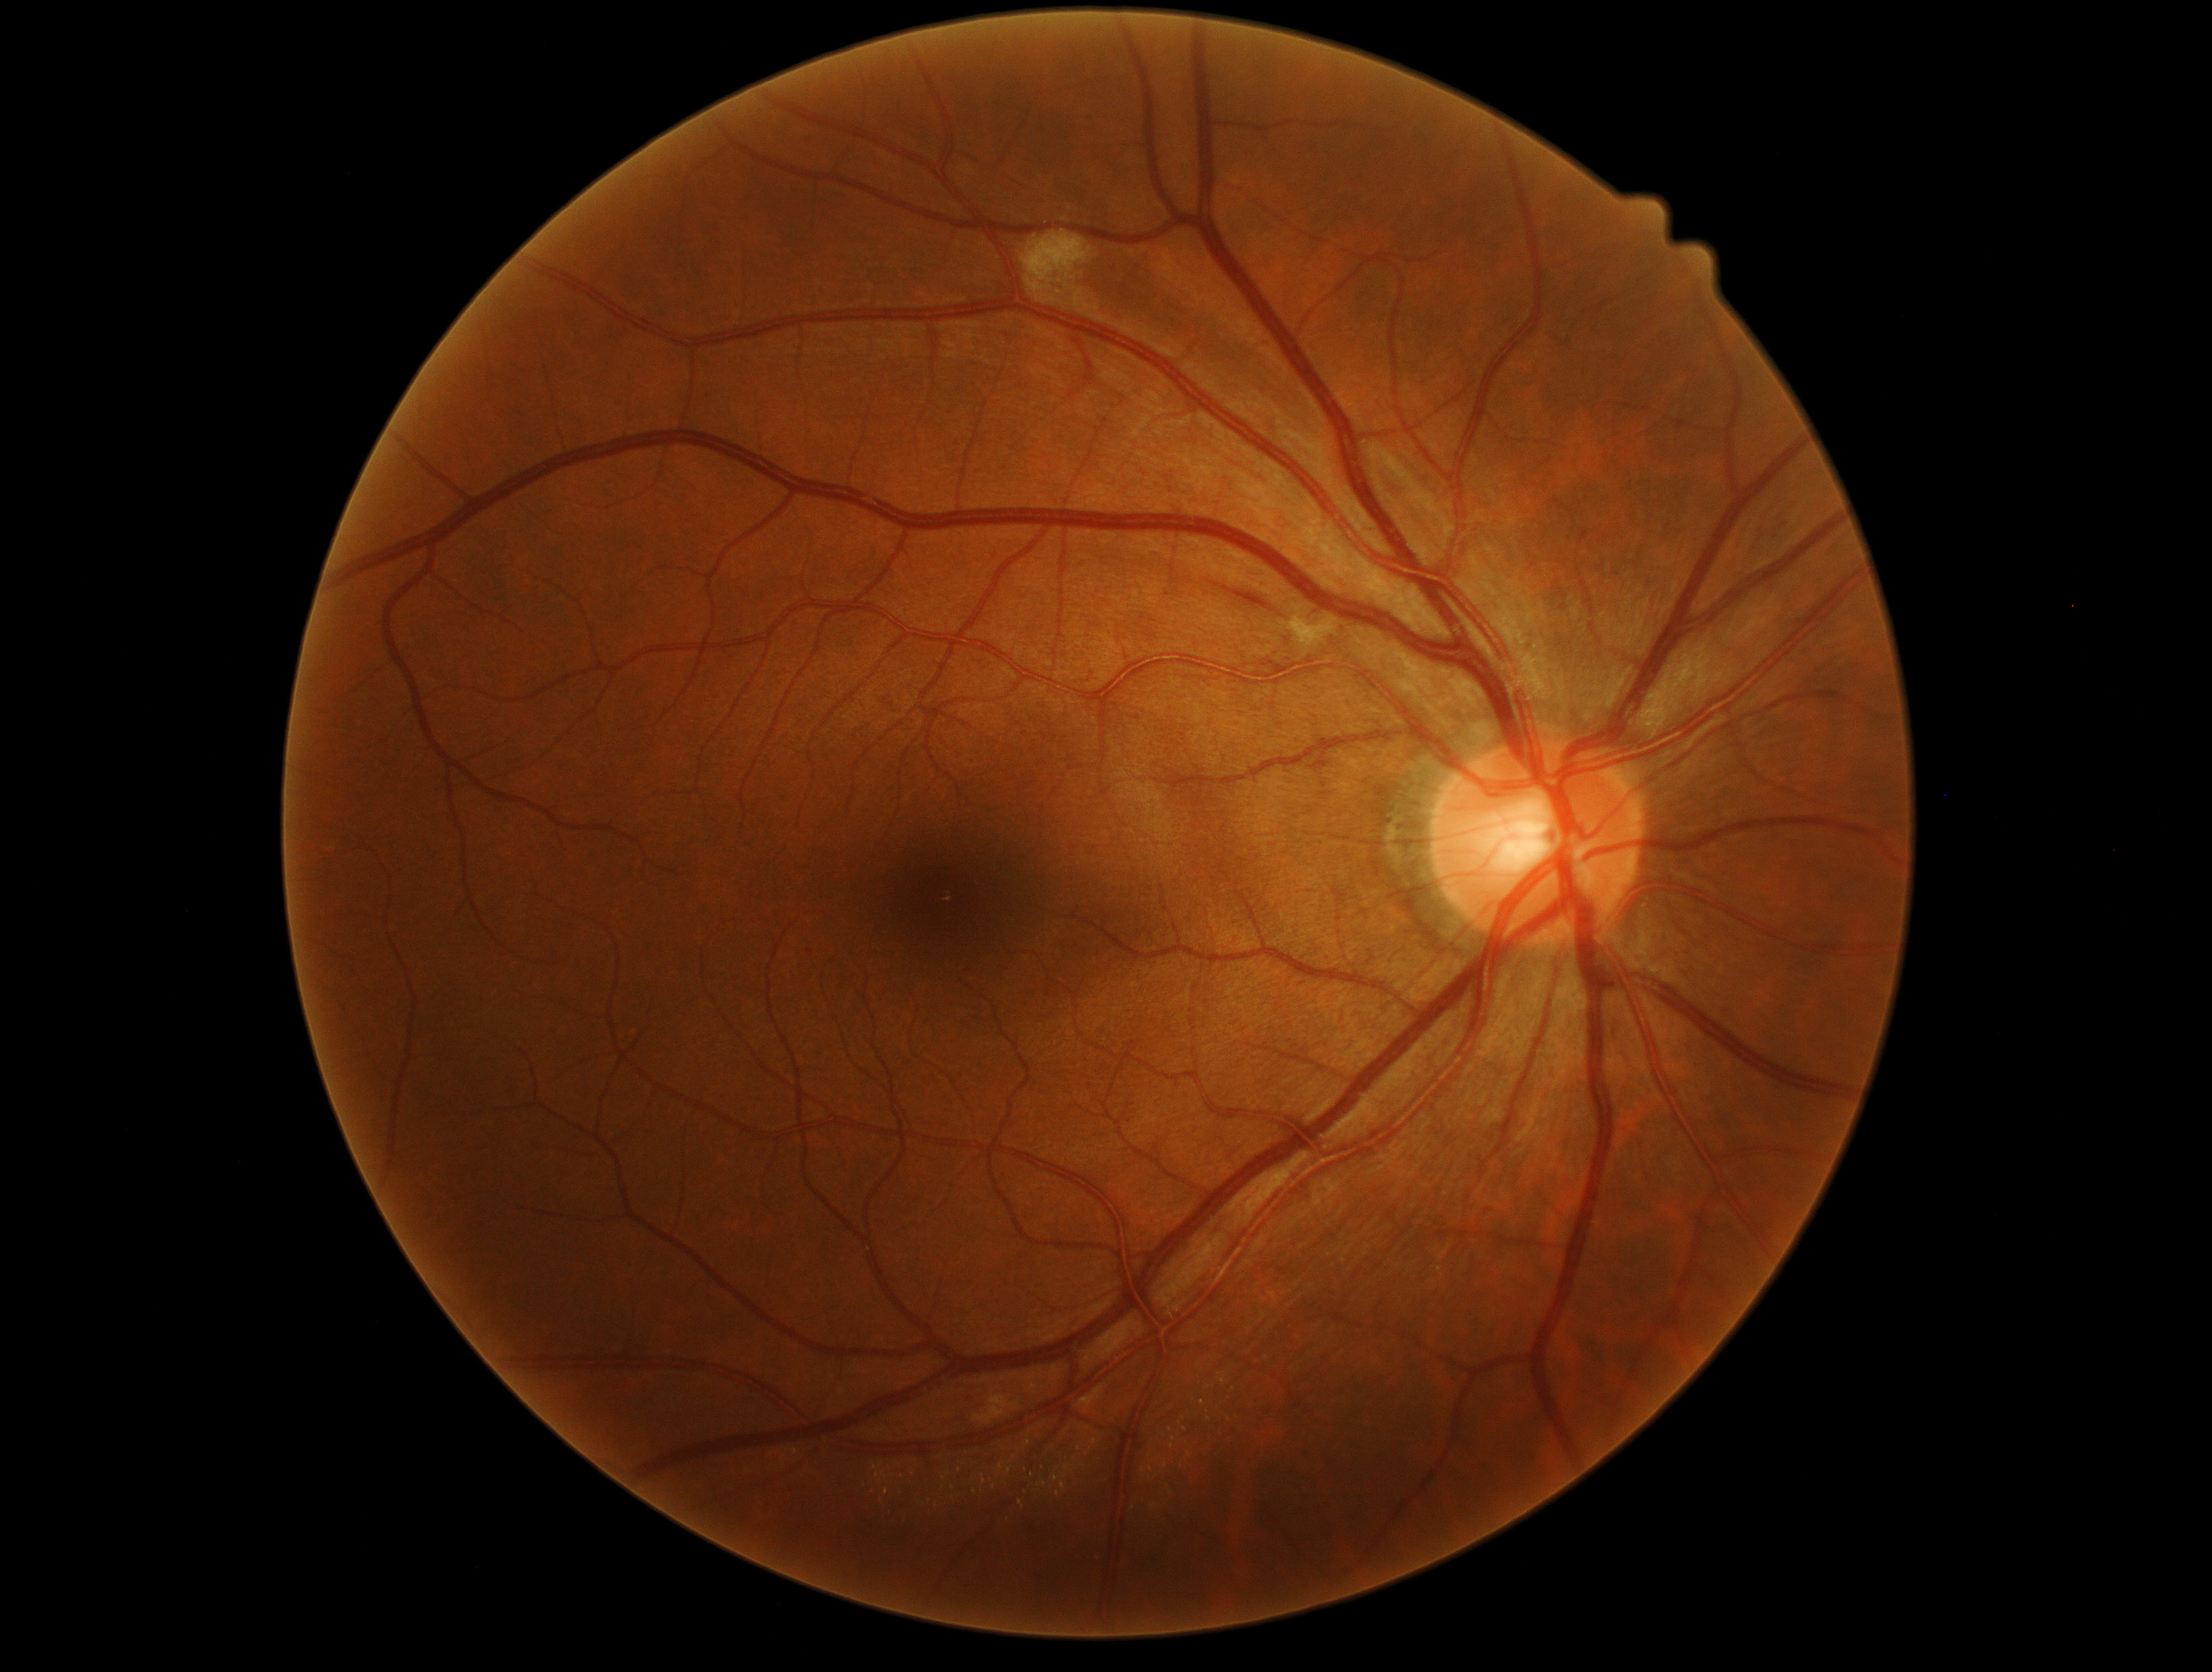   dr_grade: grade 2 (moderate NPDR)